2089 by 1764 pixels; color fundus image.
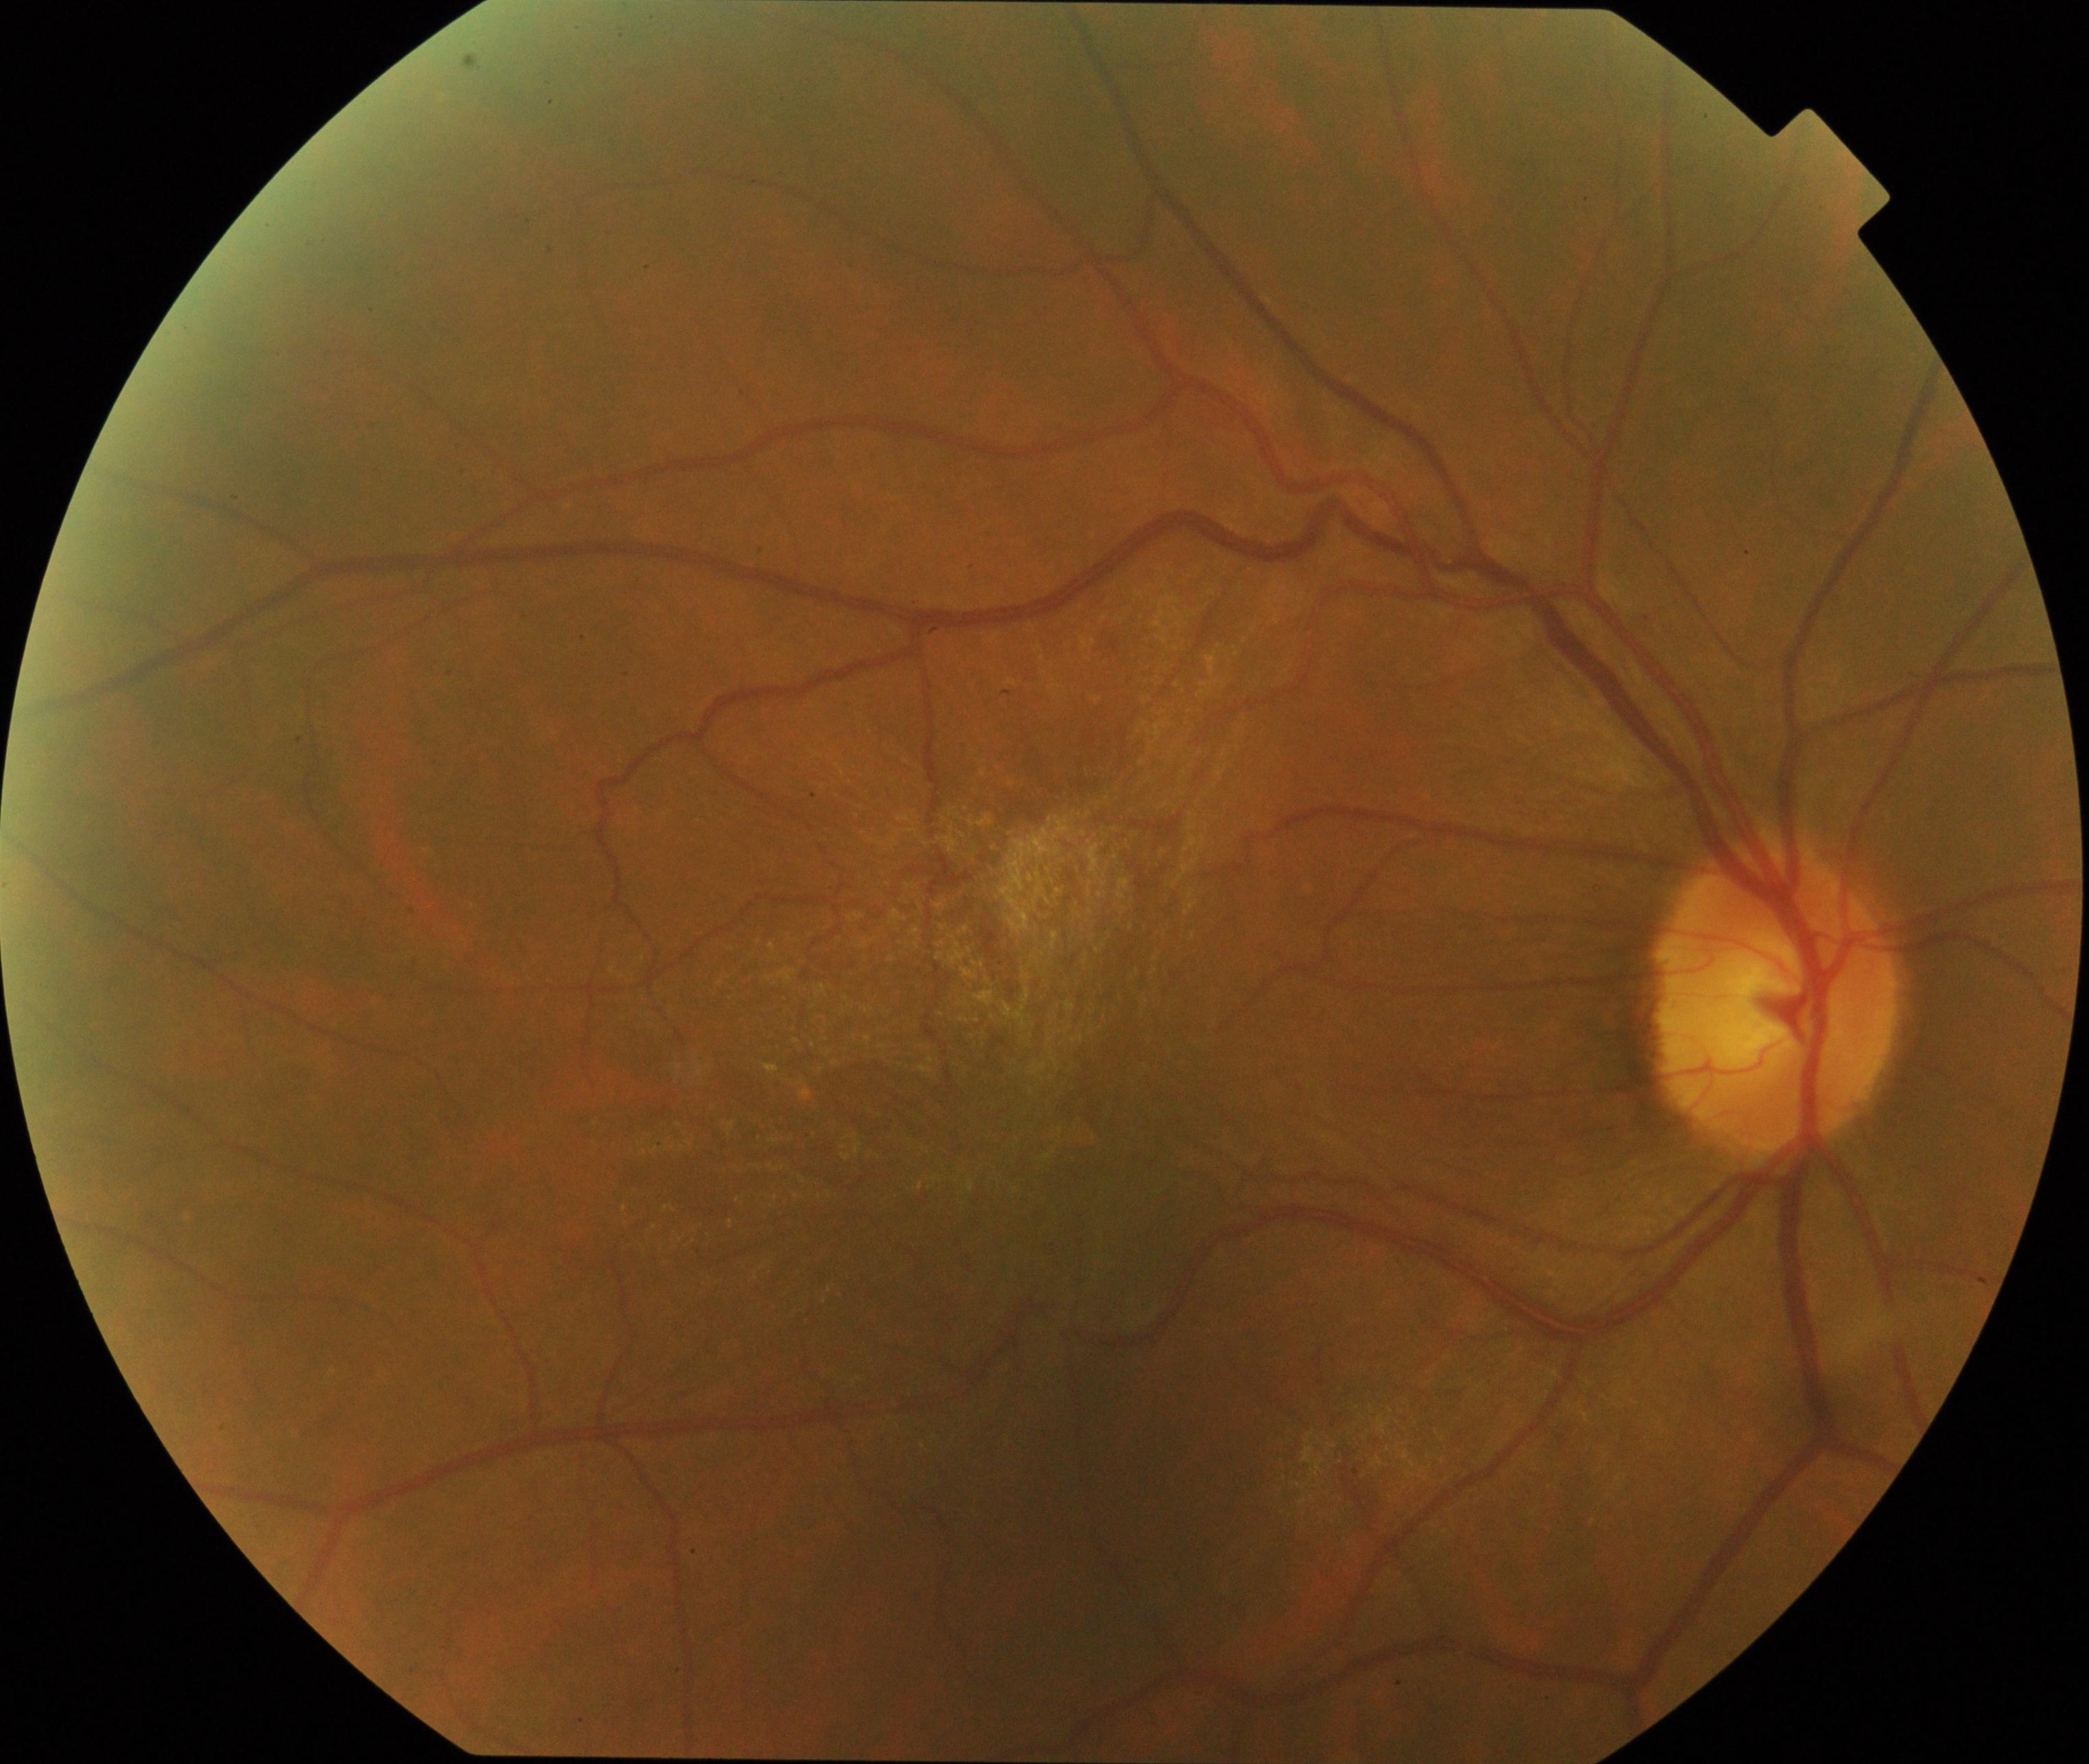
Classification: epiretinal membrane.